Image size 2048x1536
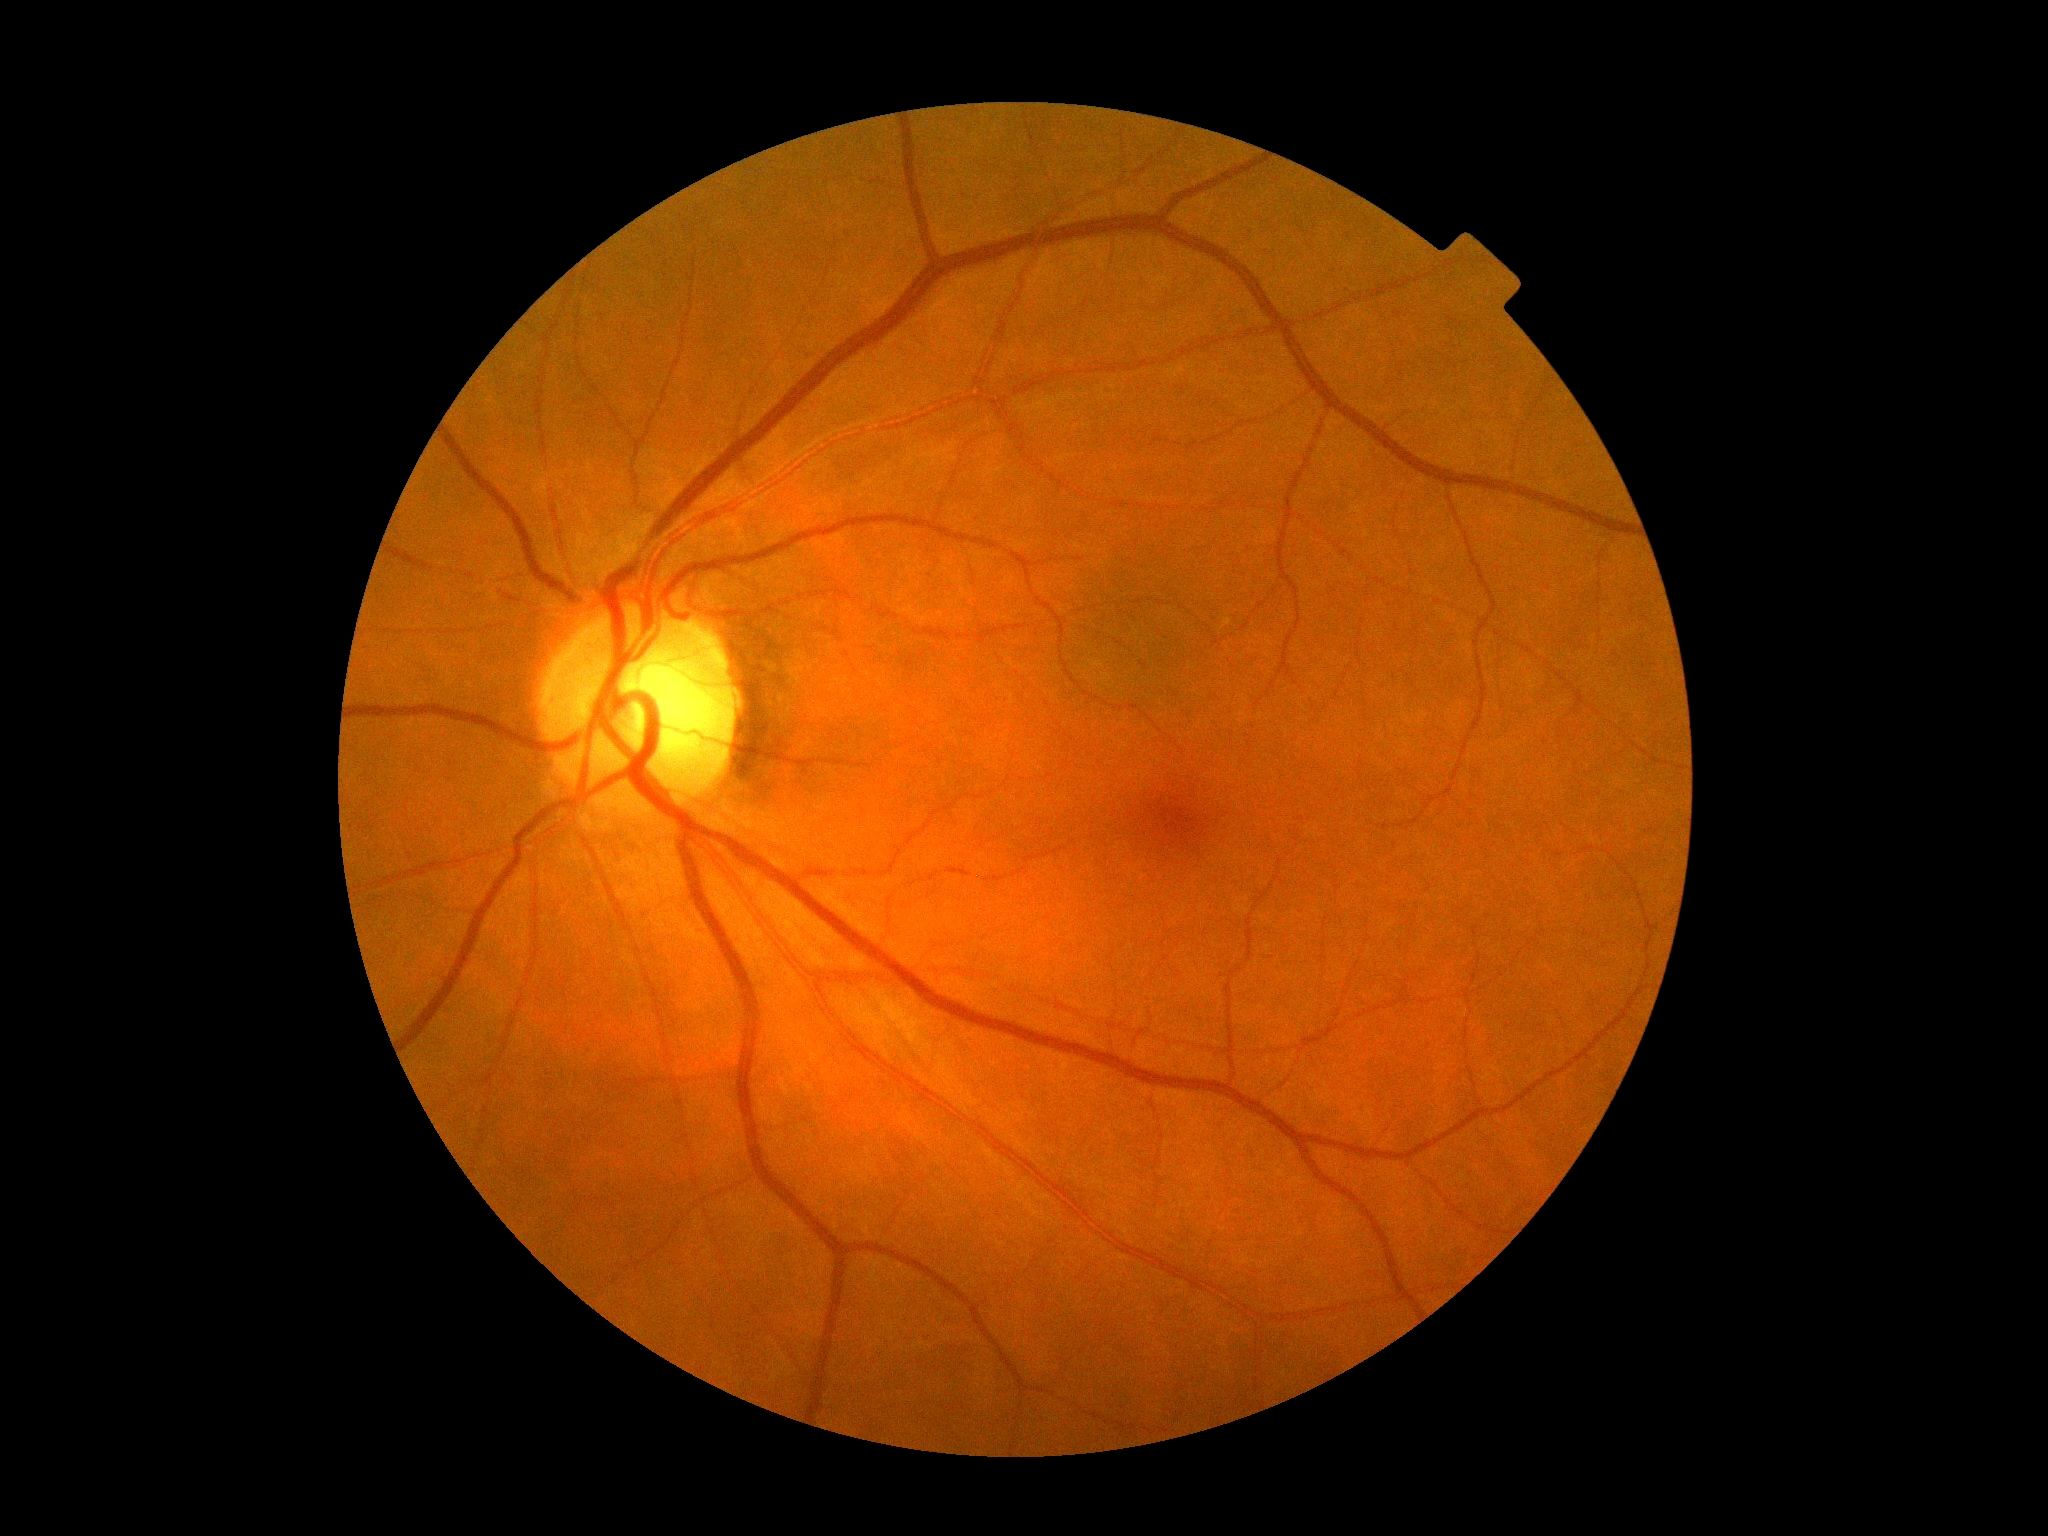

DR stage: 0/4. No apparent diabetic retinopathy.